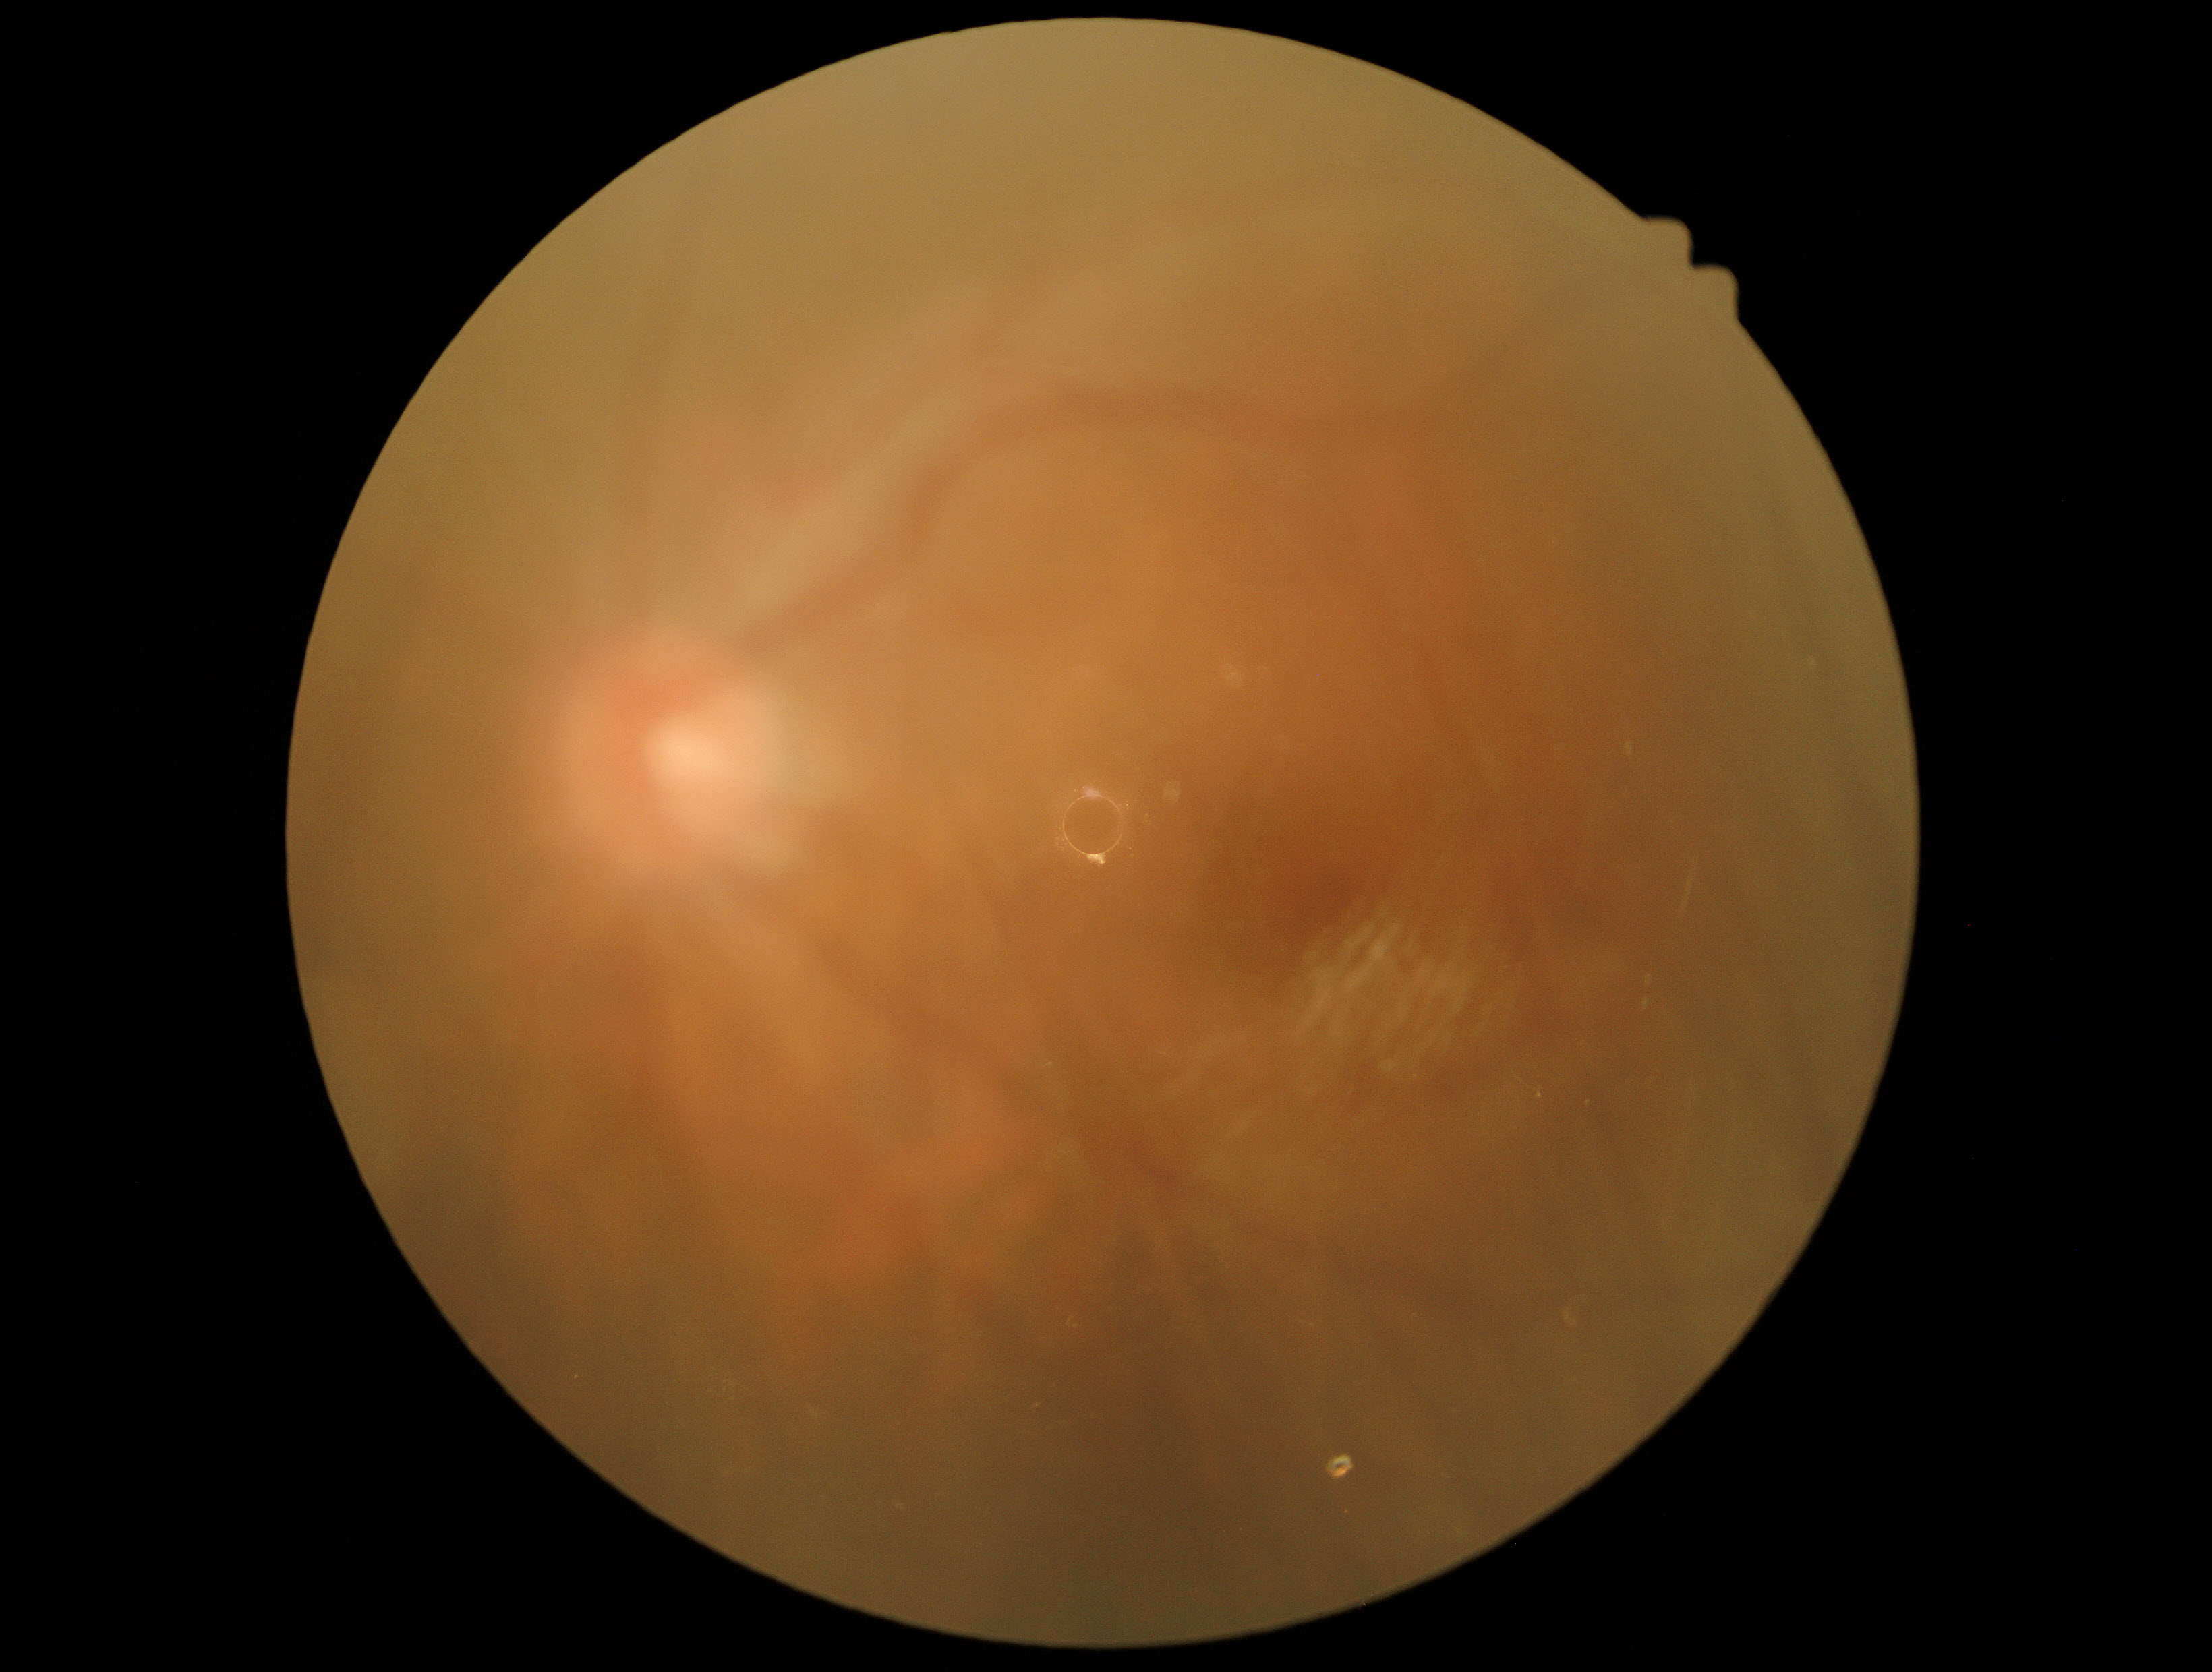
quality: below grading threshold
dr_grade: ungradable